Color fundus photograph. 2212x1659. 45° FOV:
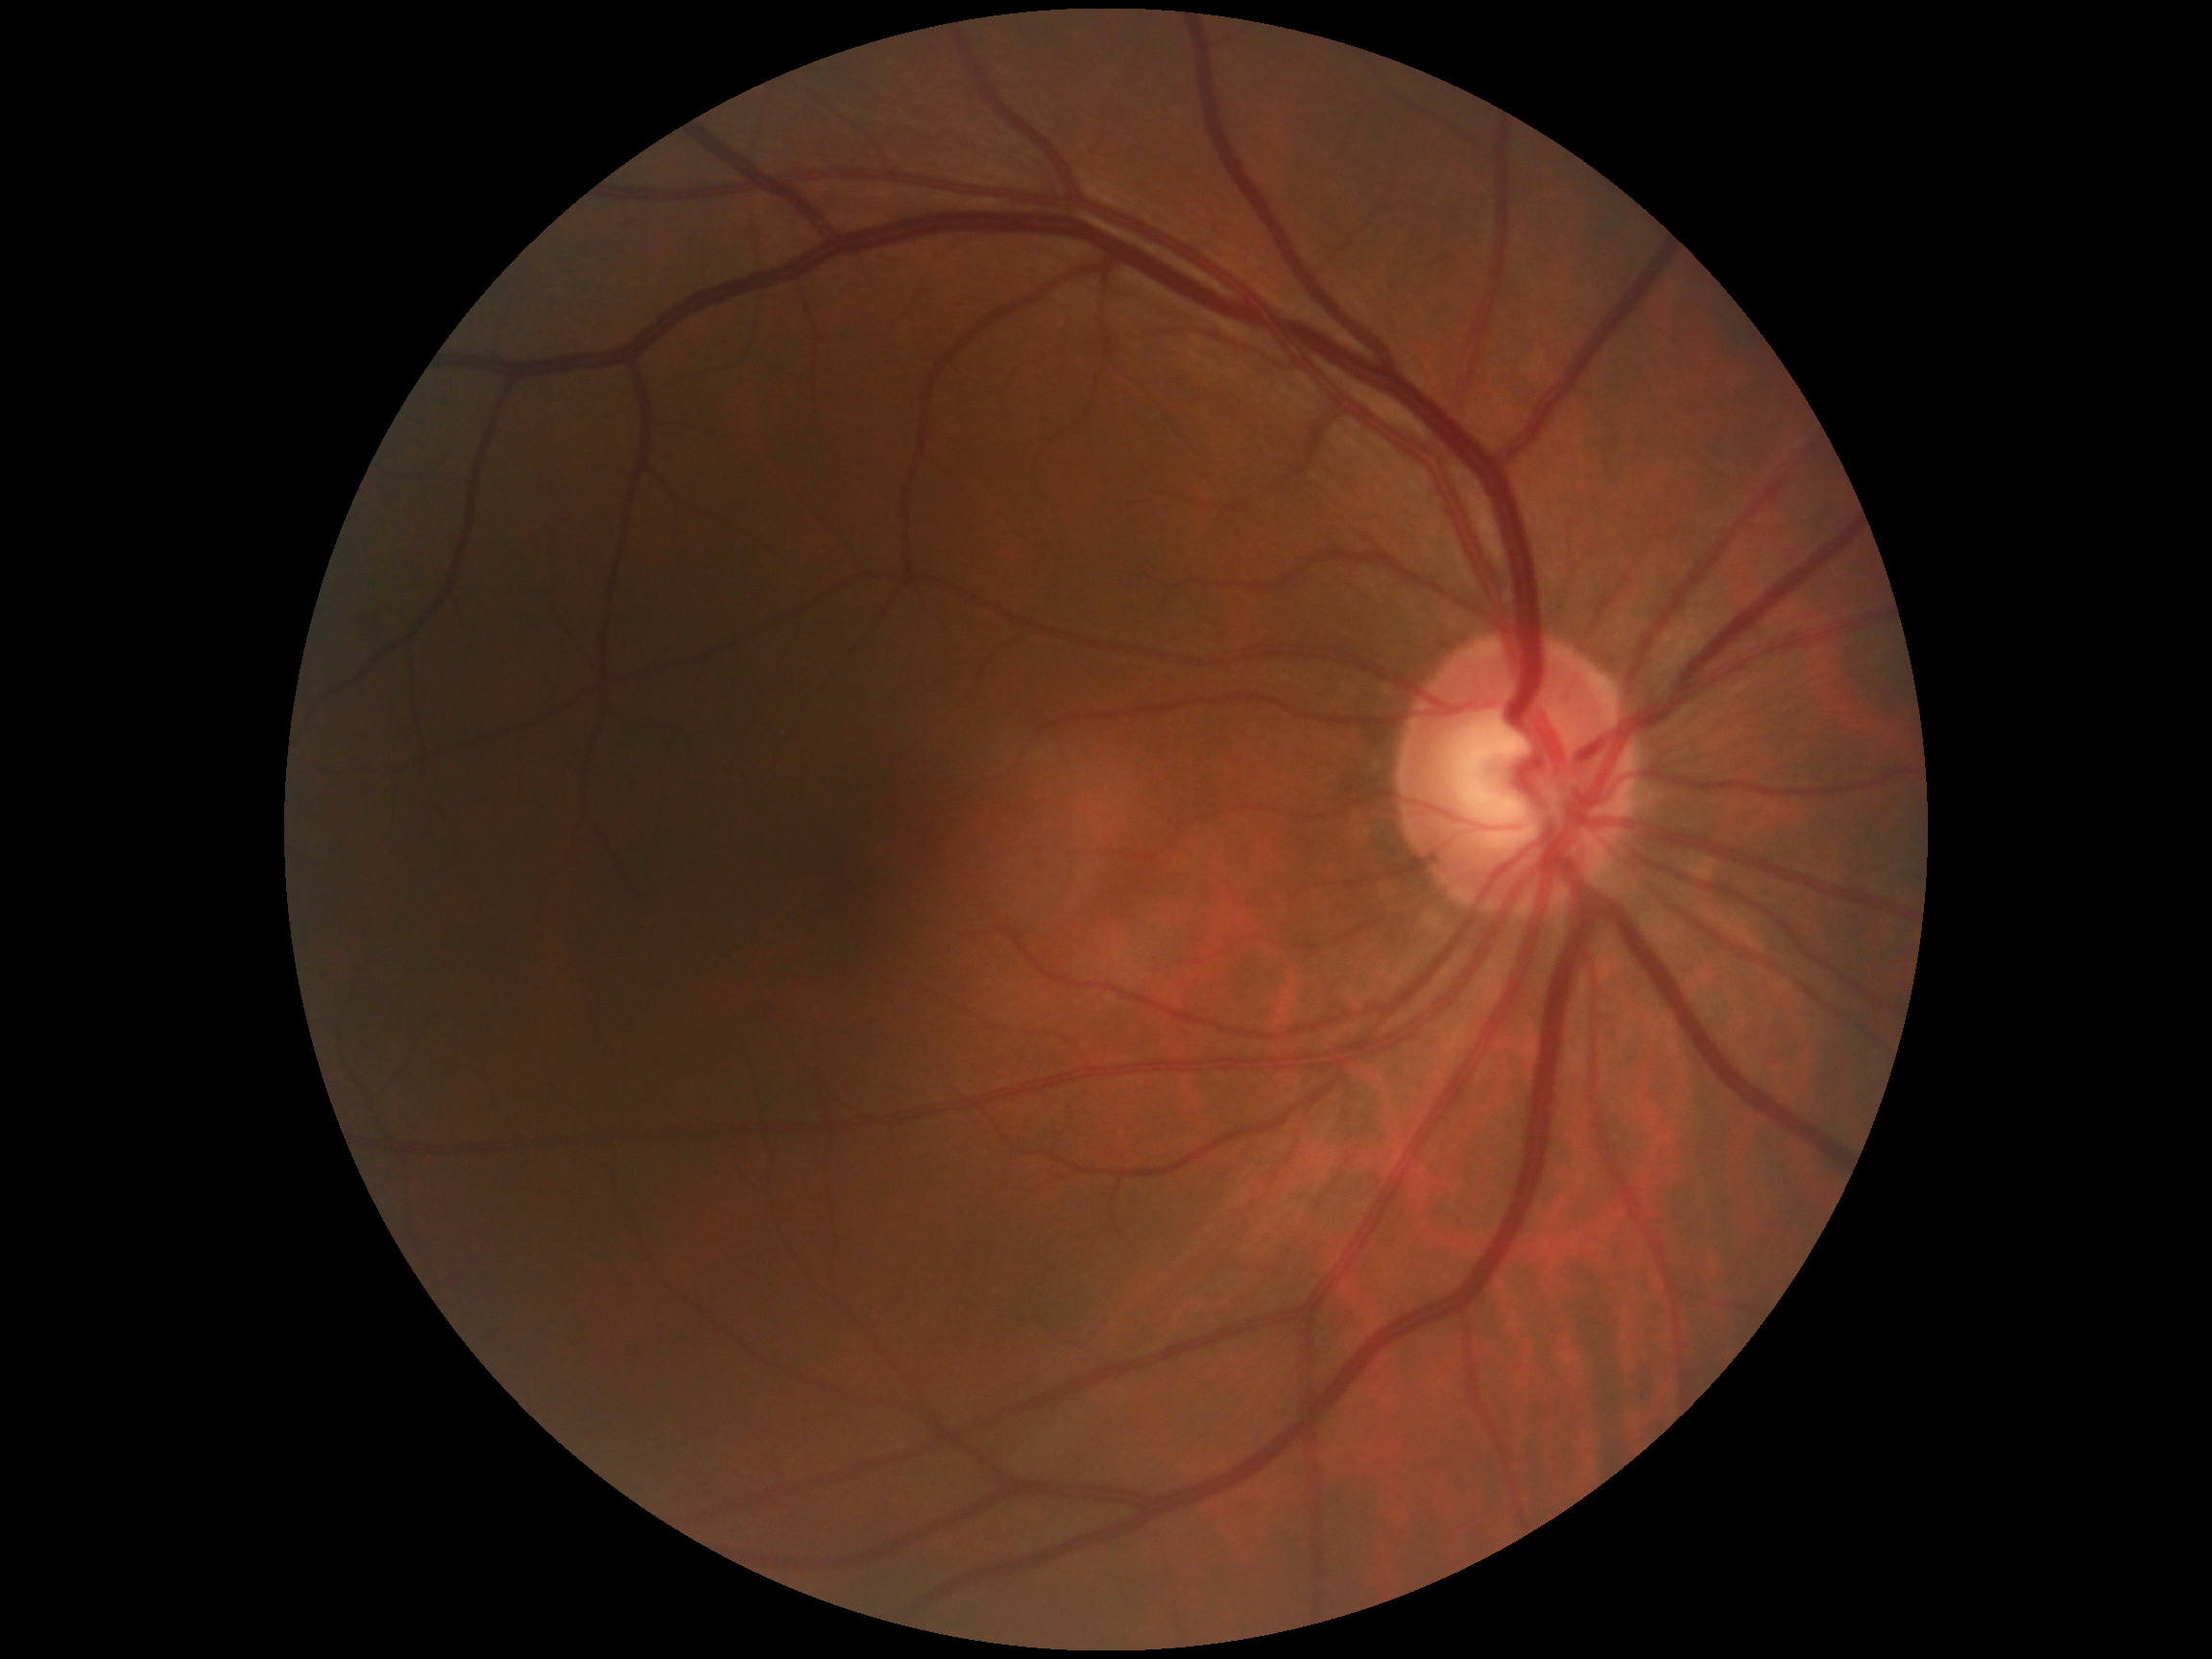

Retinopathy is grade 0 (no apparent retinopathy). No diabetic retinal disease findings.